Color fundus image. Modified Davis grading. Nonmydriatic: 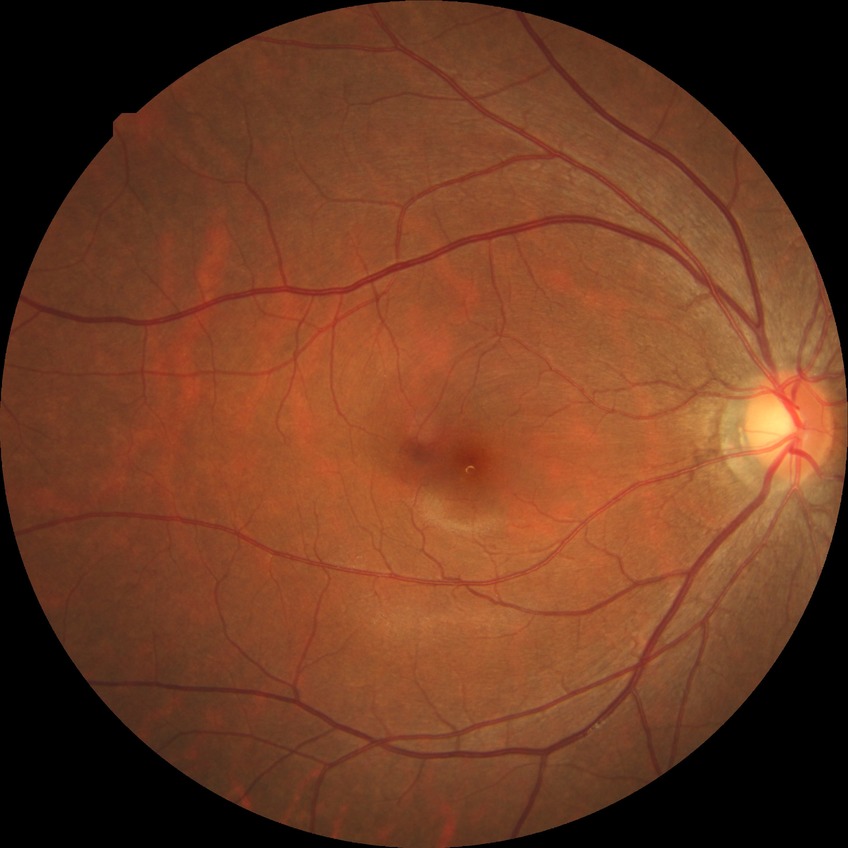

Diabetic retinopathy (DR): no diabetic retinopathy (NDR).